2346x1568, color fundus image, 45-degree field of view
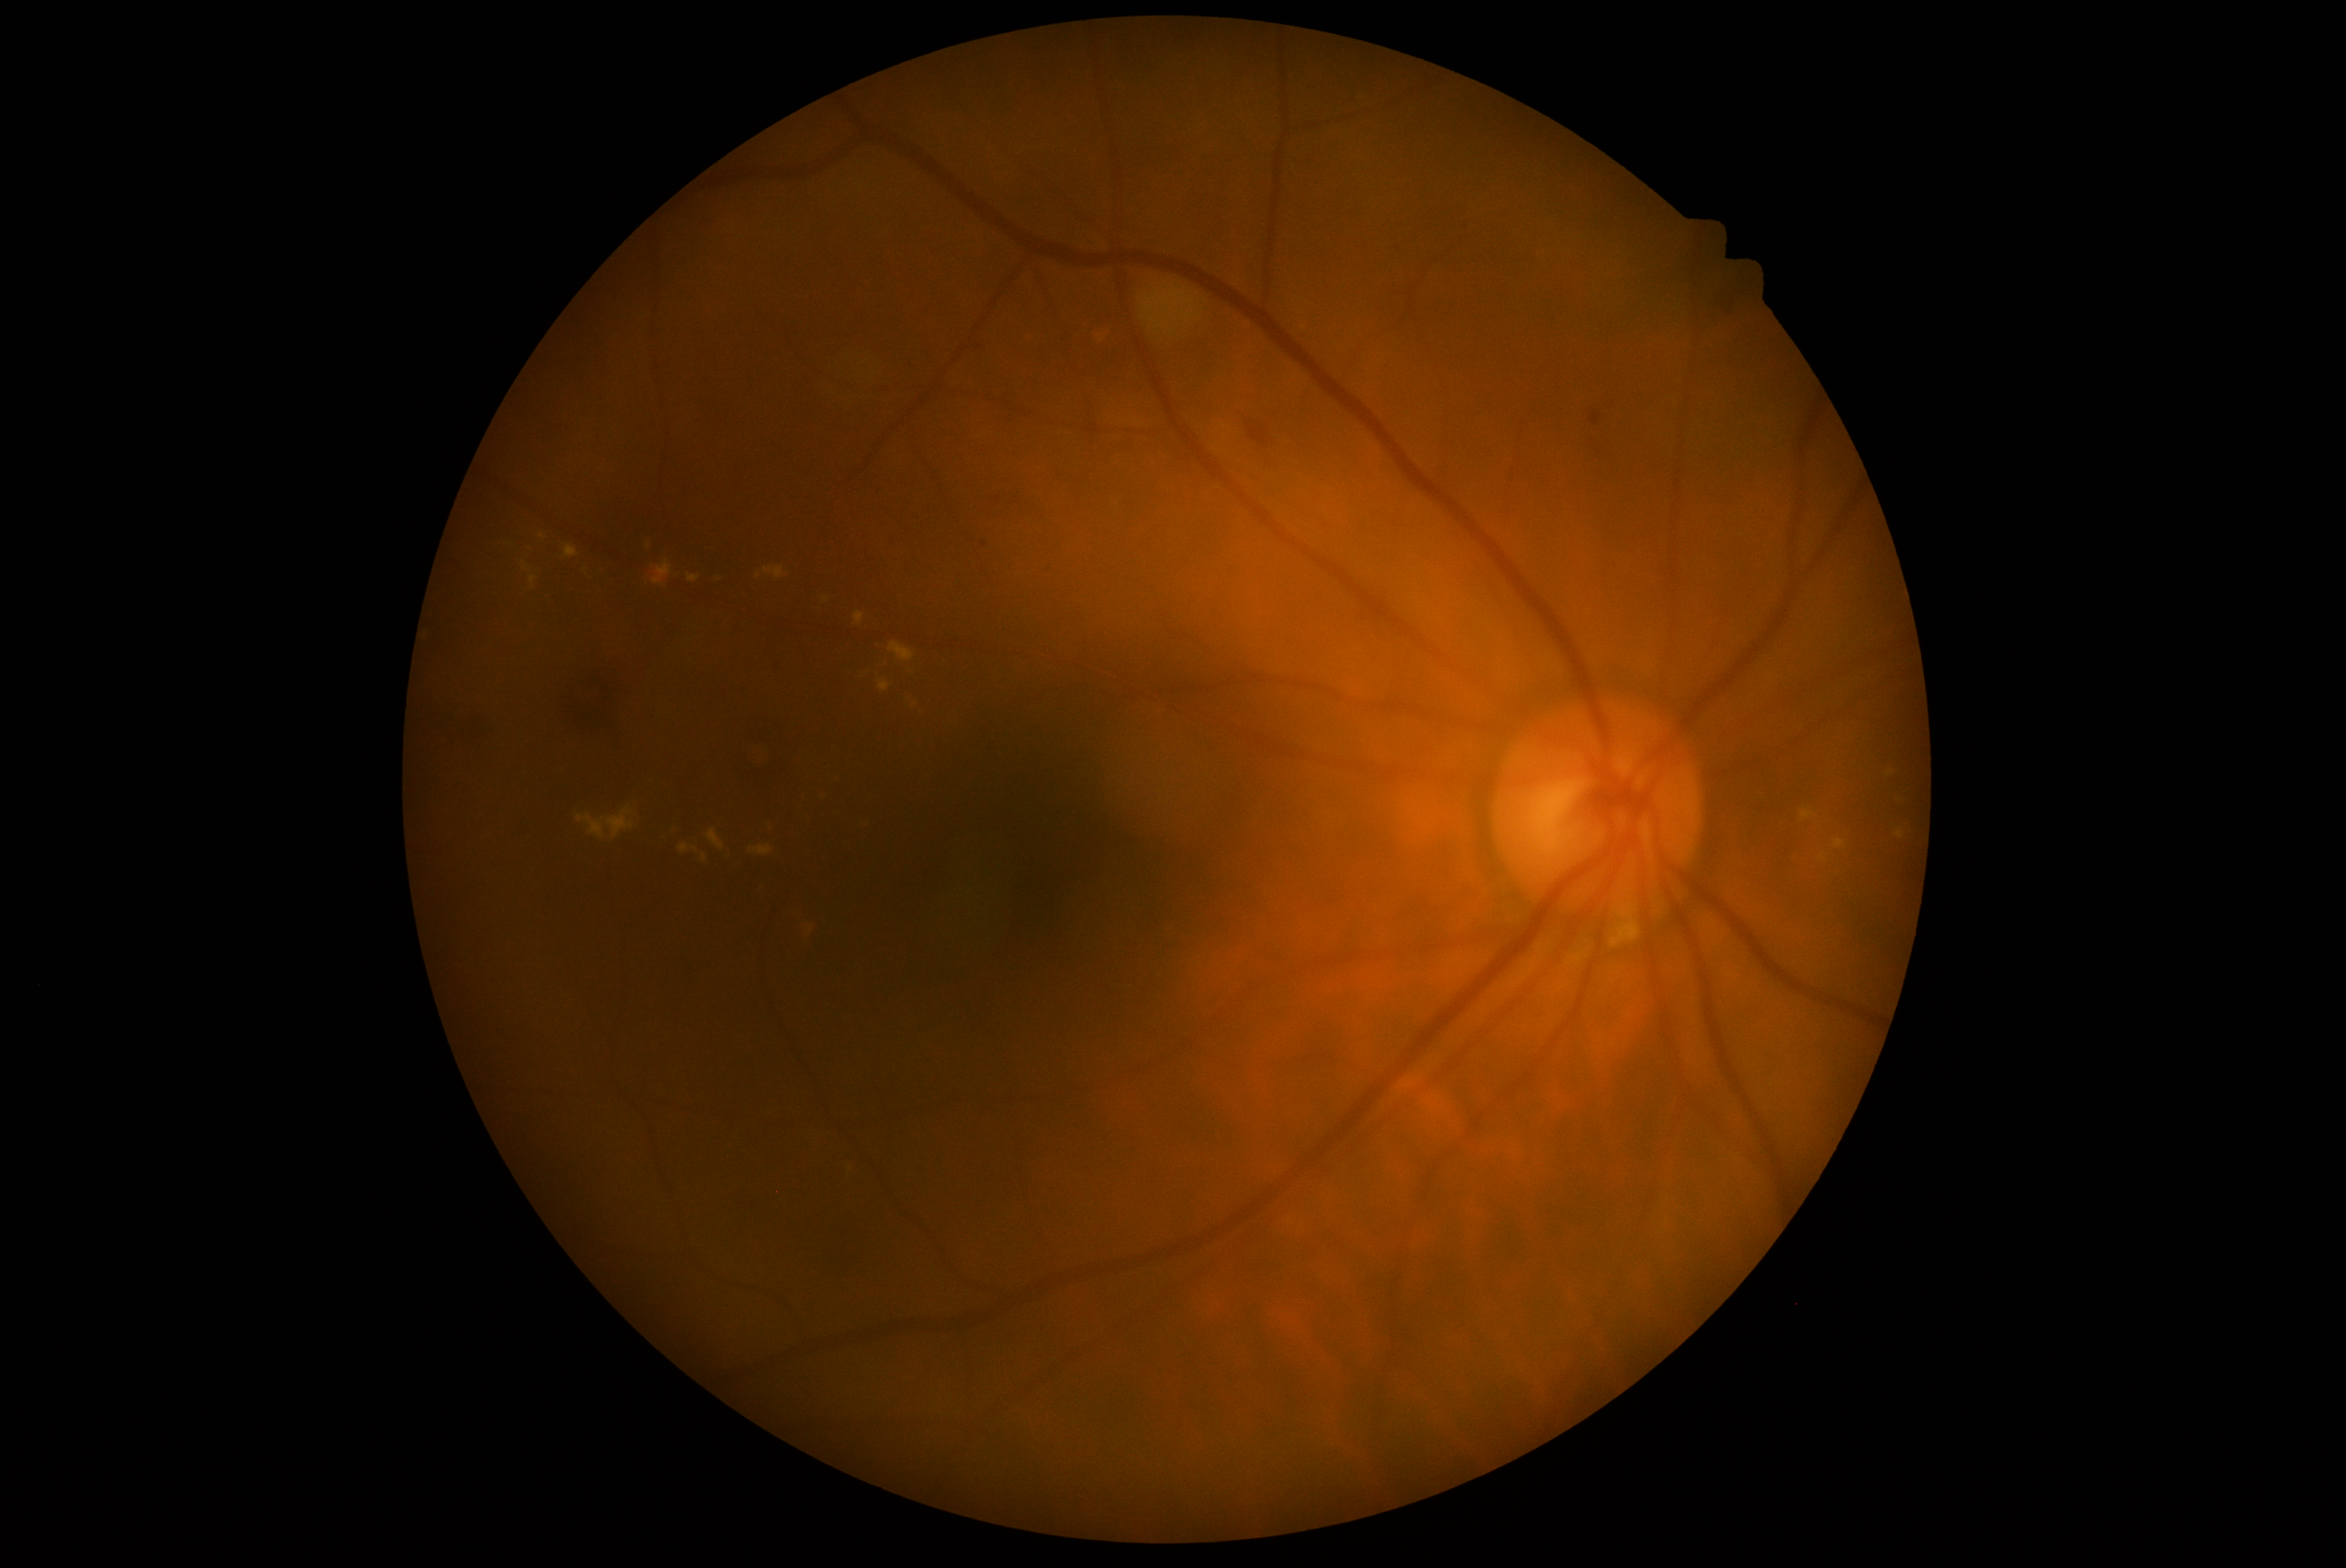
retinopathy = grade 2 (moderate NPDR).